CFP: 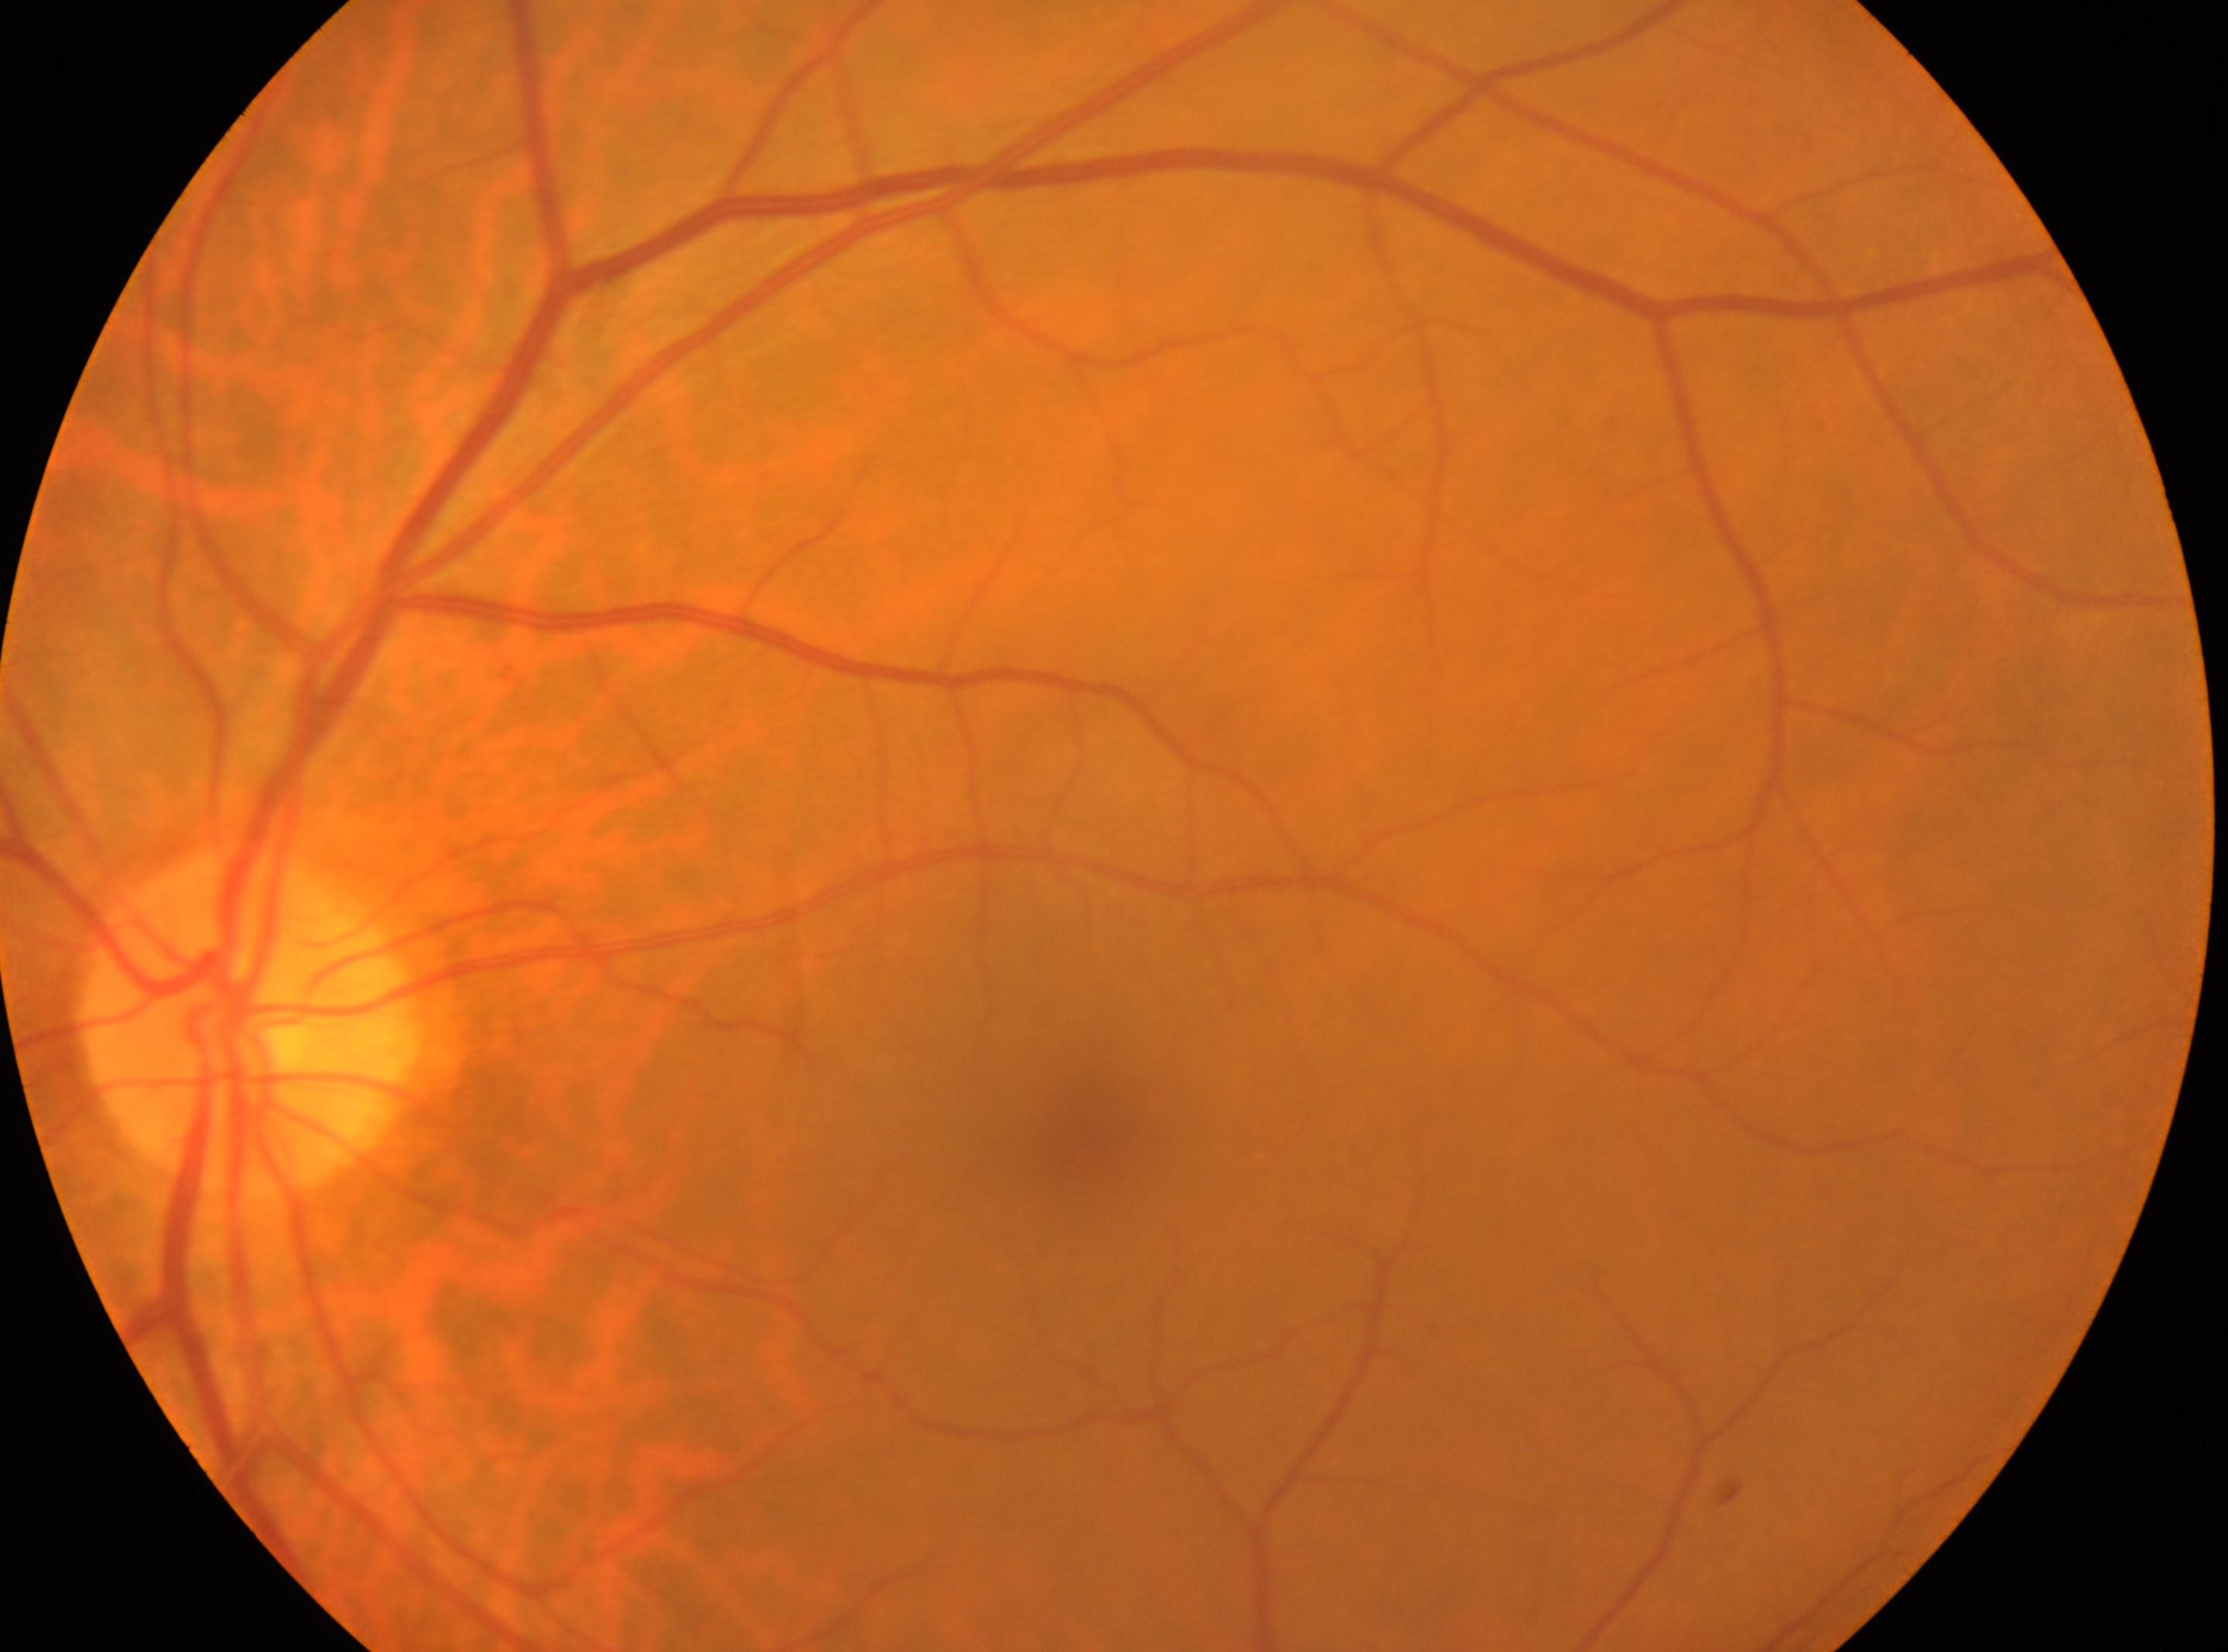 Q: DR stage?
A: 0 — no visible signs of diabetic retinopathy
Q: Right or left eye?
A: OS
Q: Optic disc center?
A: (x: 251, y: 1020)
Q: Where is the fovea?
A: (x: 1095, y: 1134)